Pediatric retinal photograph (wide-field).
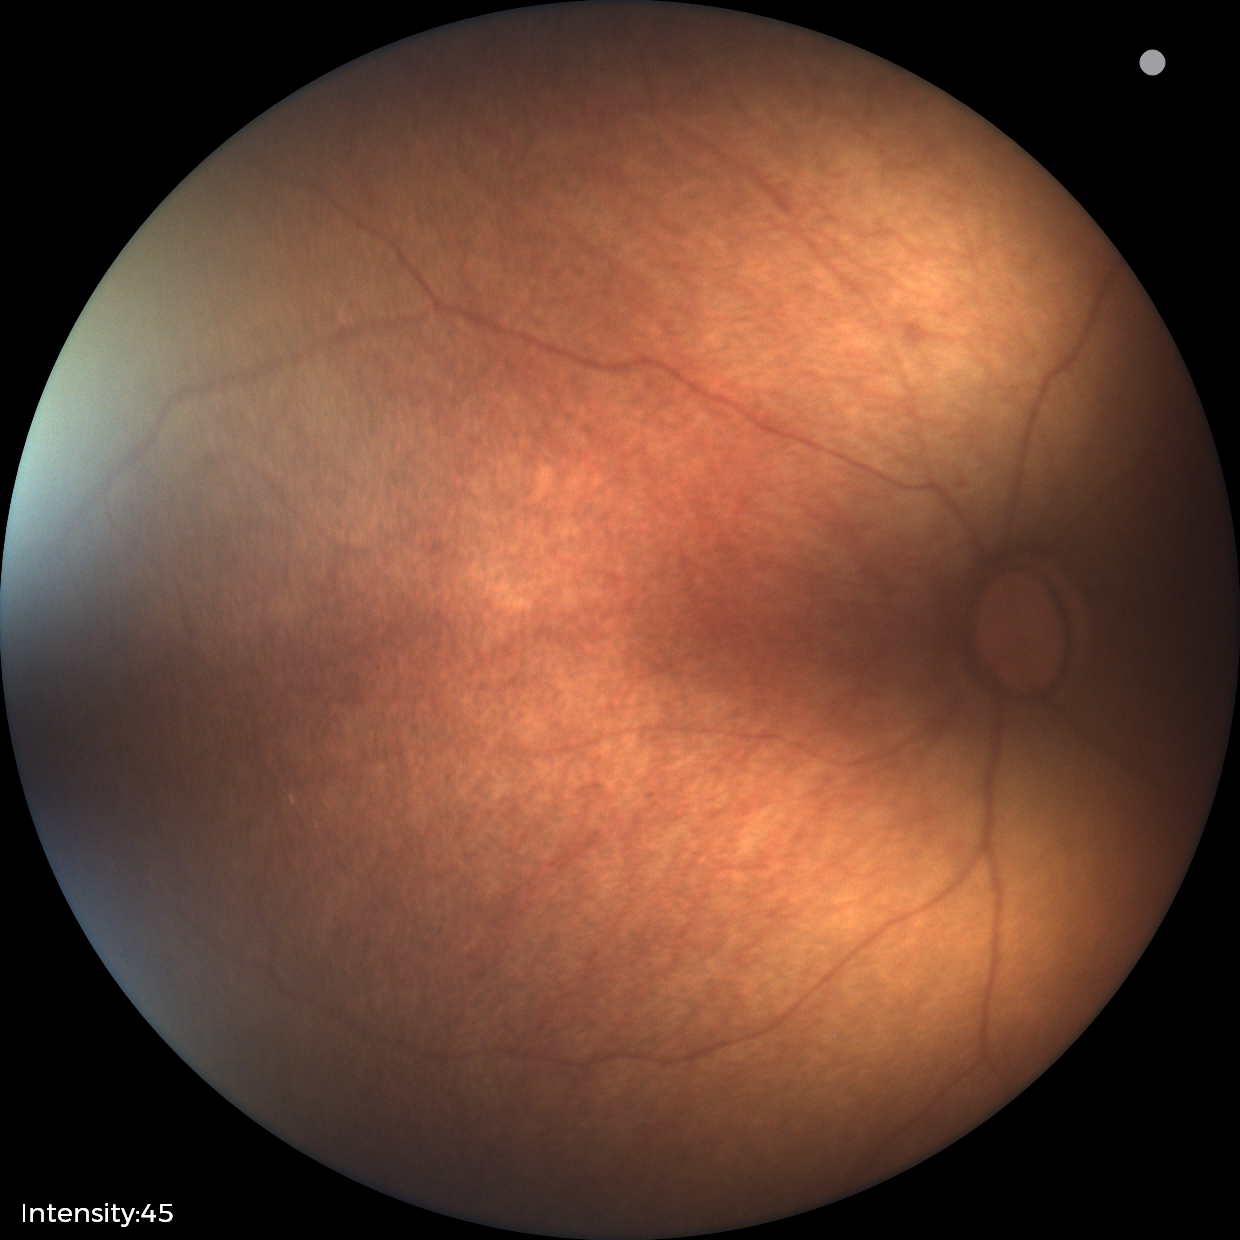 Physiological retinal appearance for postconceptual age.